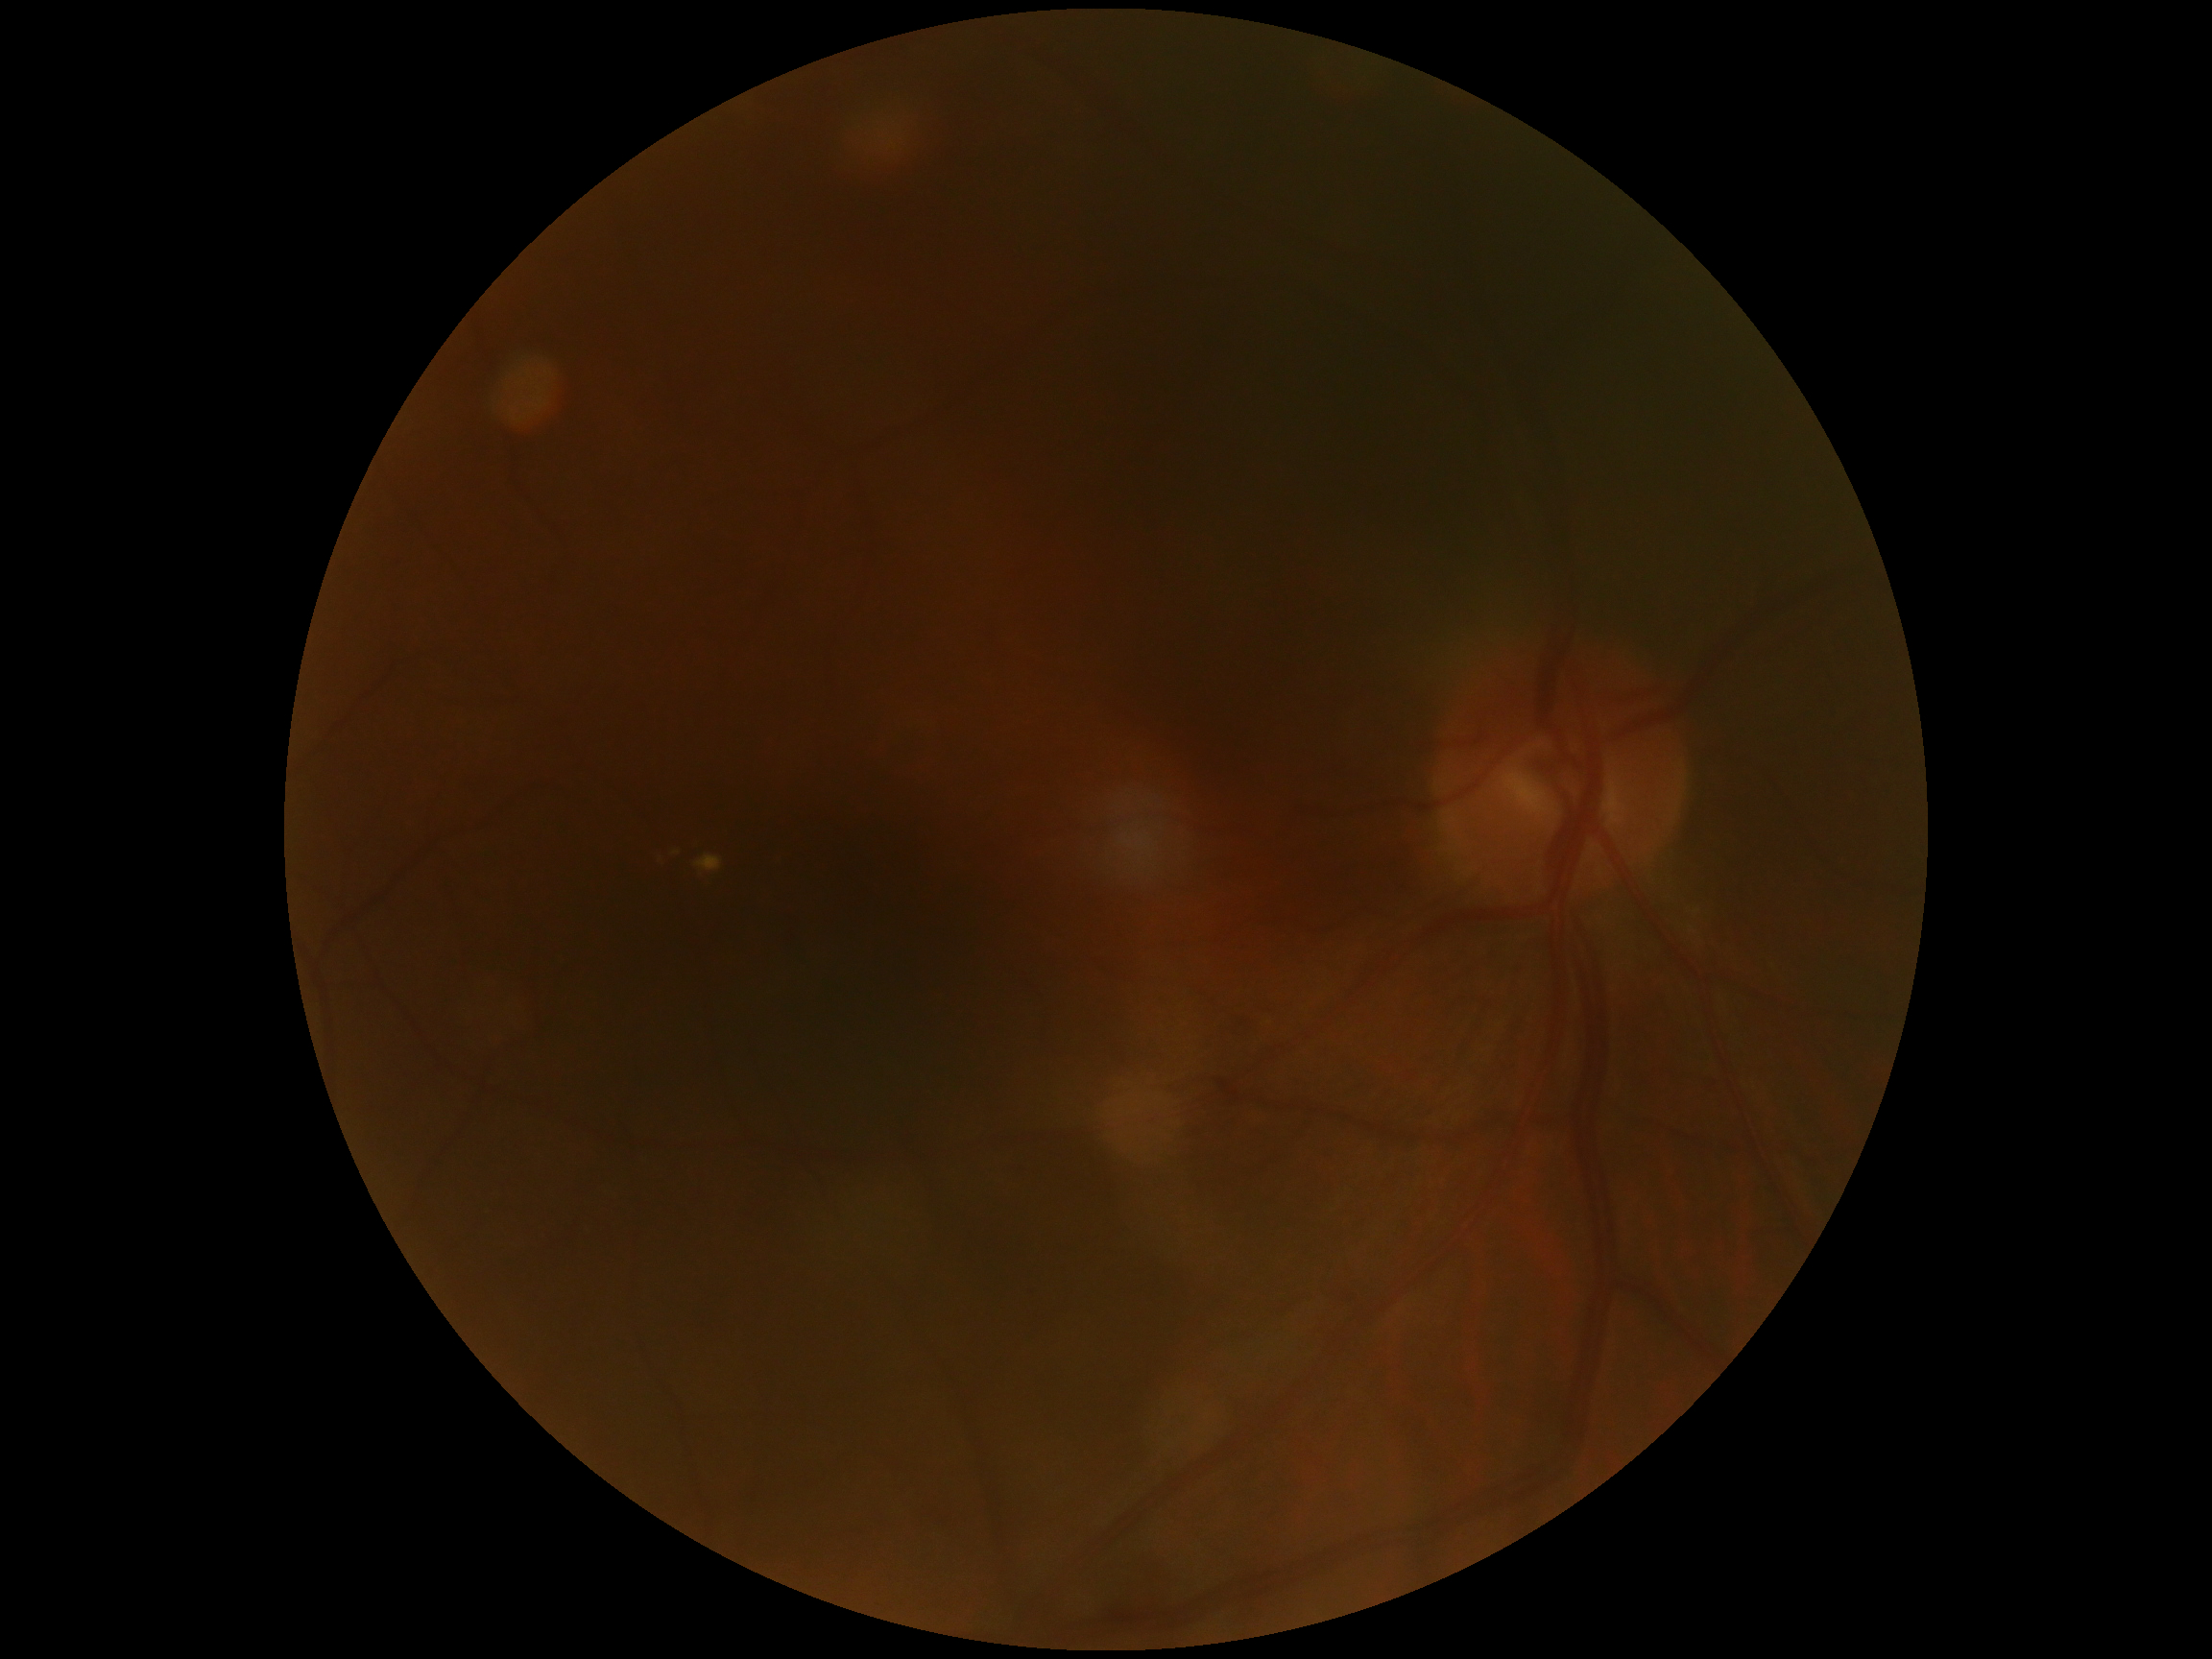
DR severity is moderate NPDR (grade 2). DR class: non-proliferative diabetic retinopathy.